Acquired with a NIDEK AFC-230. Graded on the modified Davis scale: 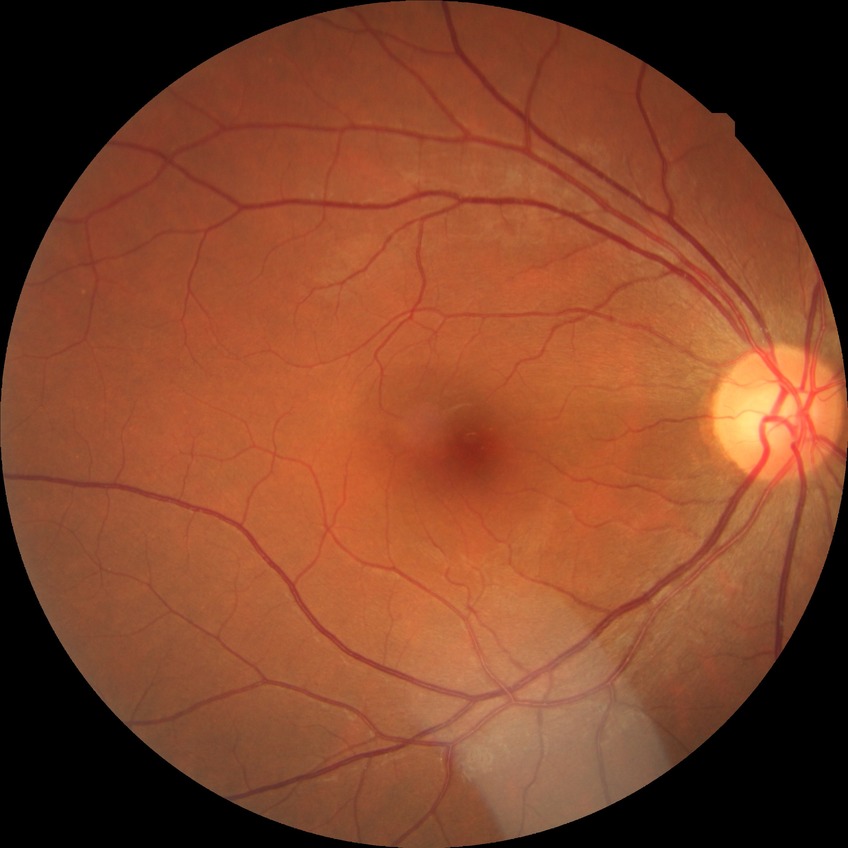
Assessment:
• diabetic retinopathy (DR) — no diabetic retinopathy (NDR)